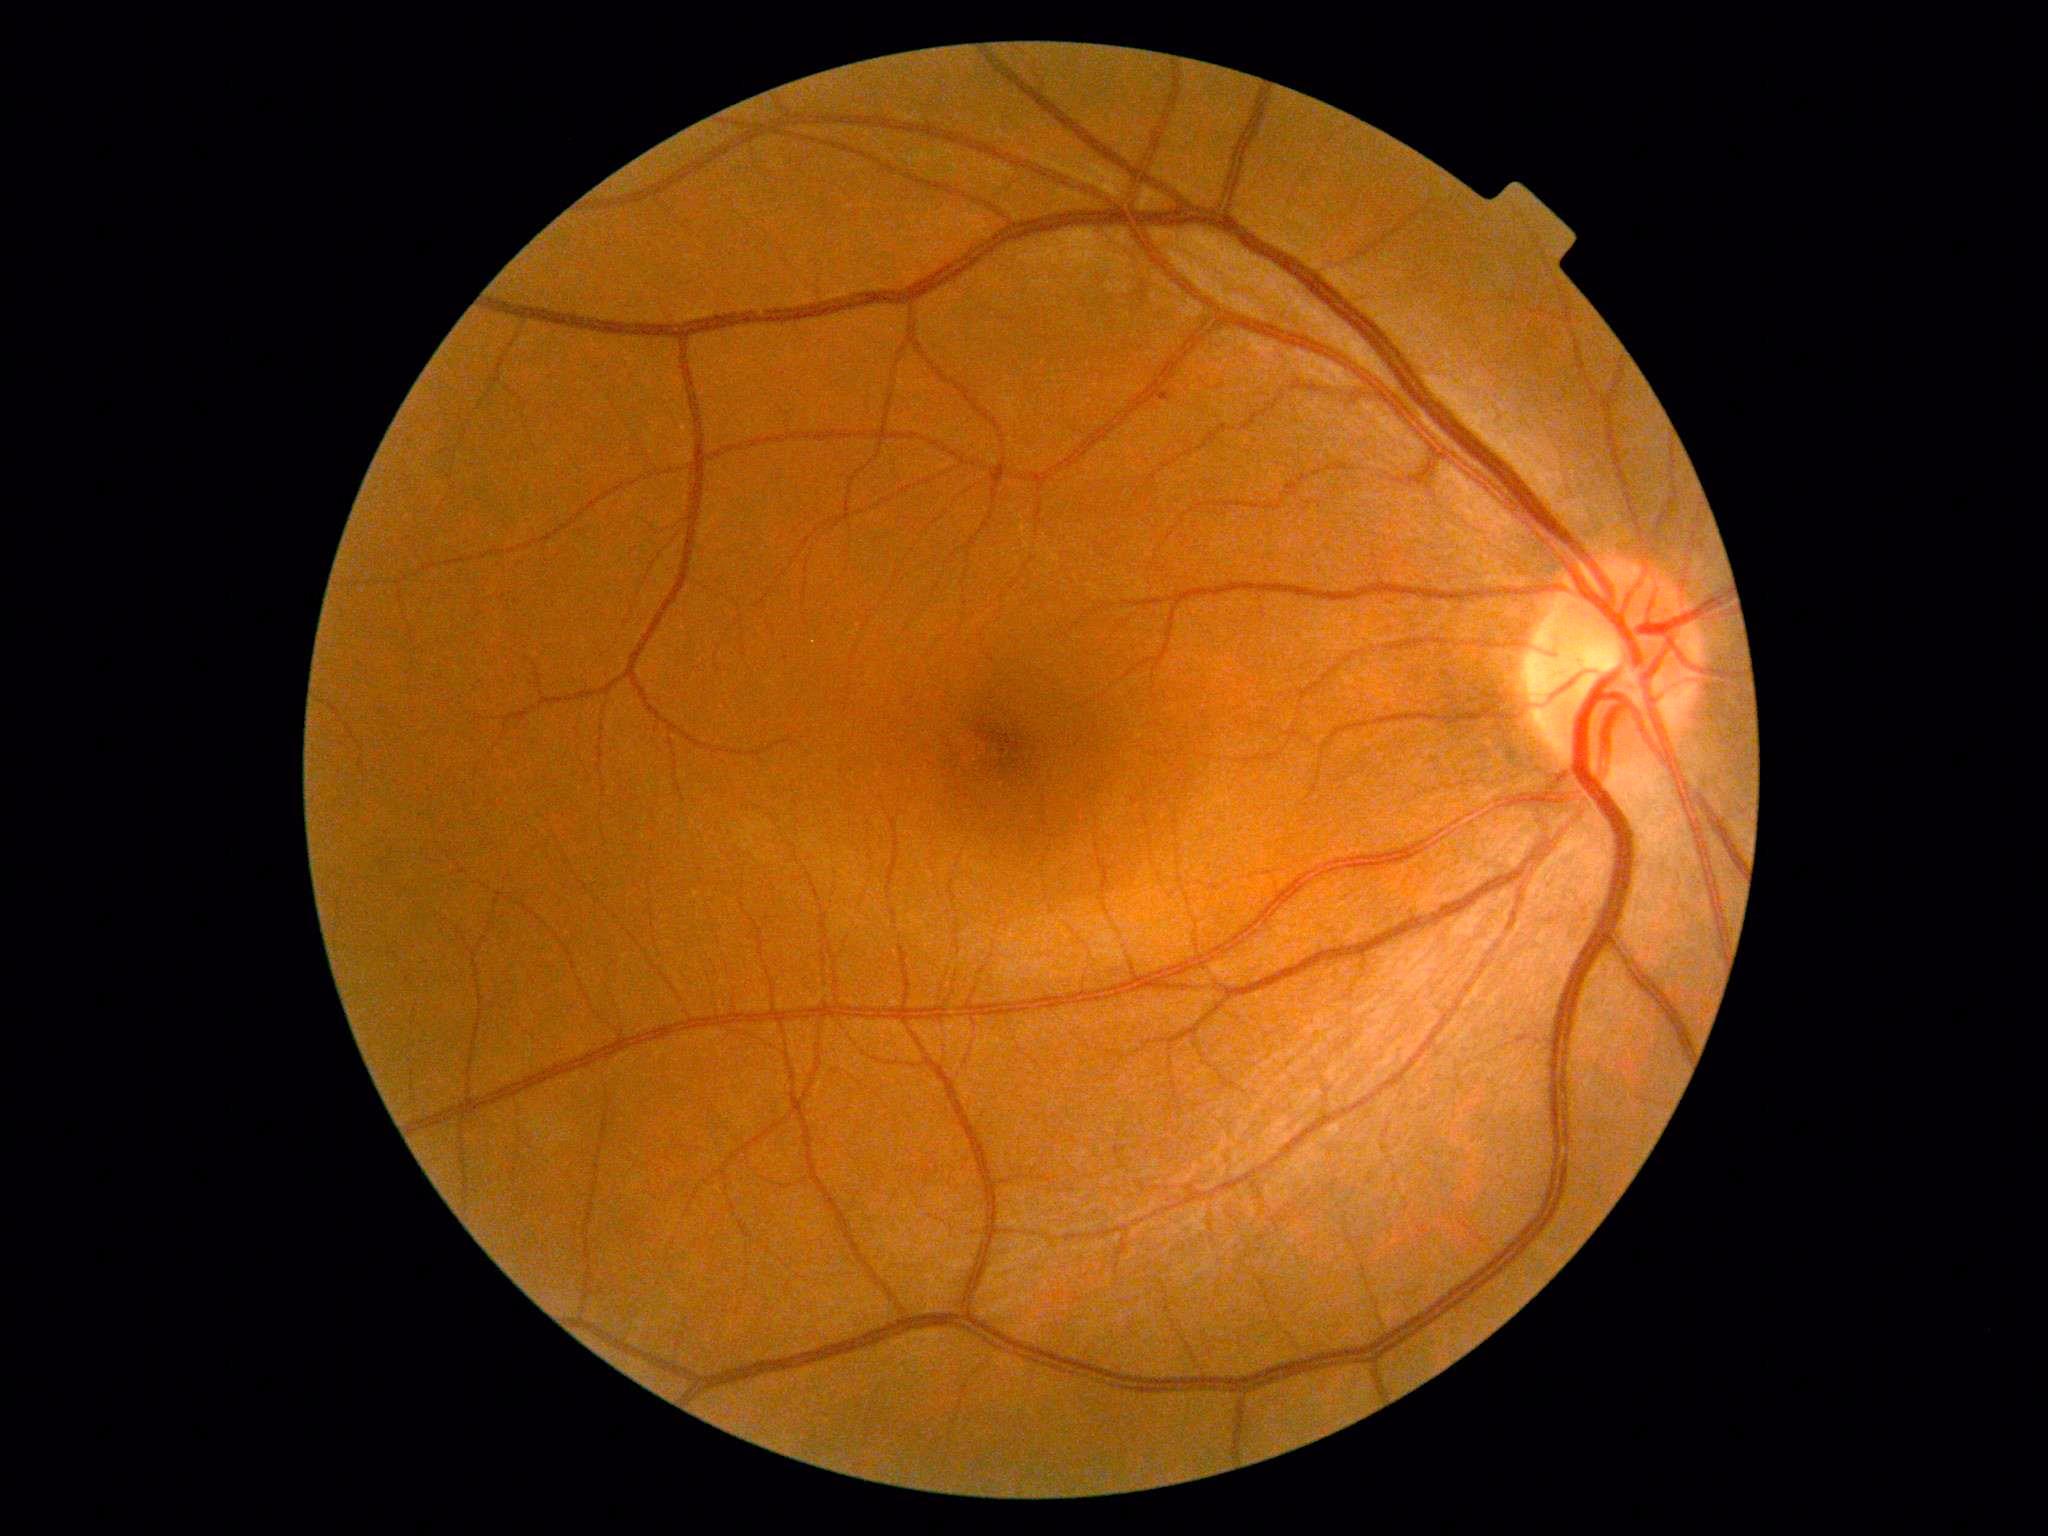 • DR grade — mild NPDR (1) — presence of microaneurysms only